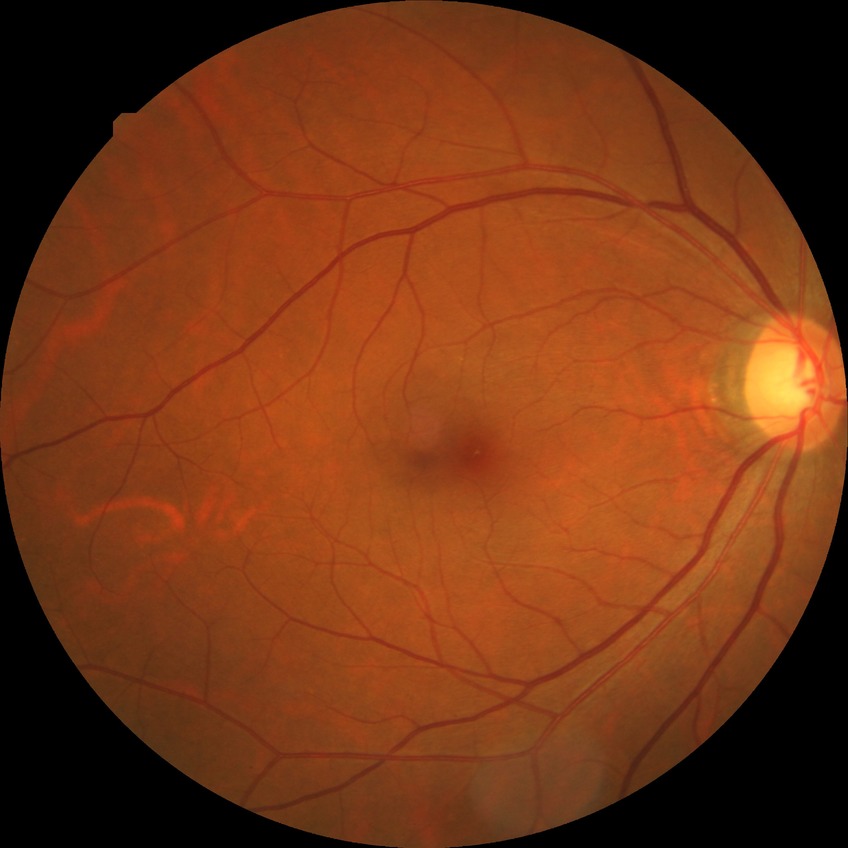
No signs of diabetic retinopathy. Davis grade is NDR.